2048x1536. 45-degree field of view: 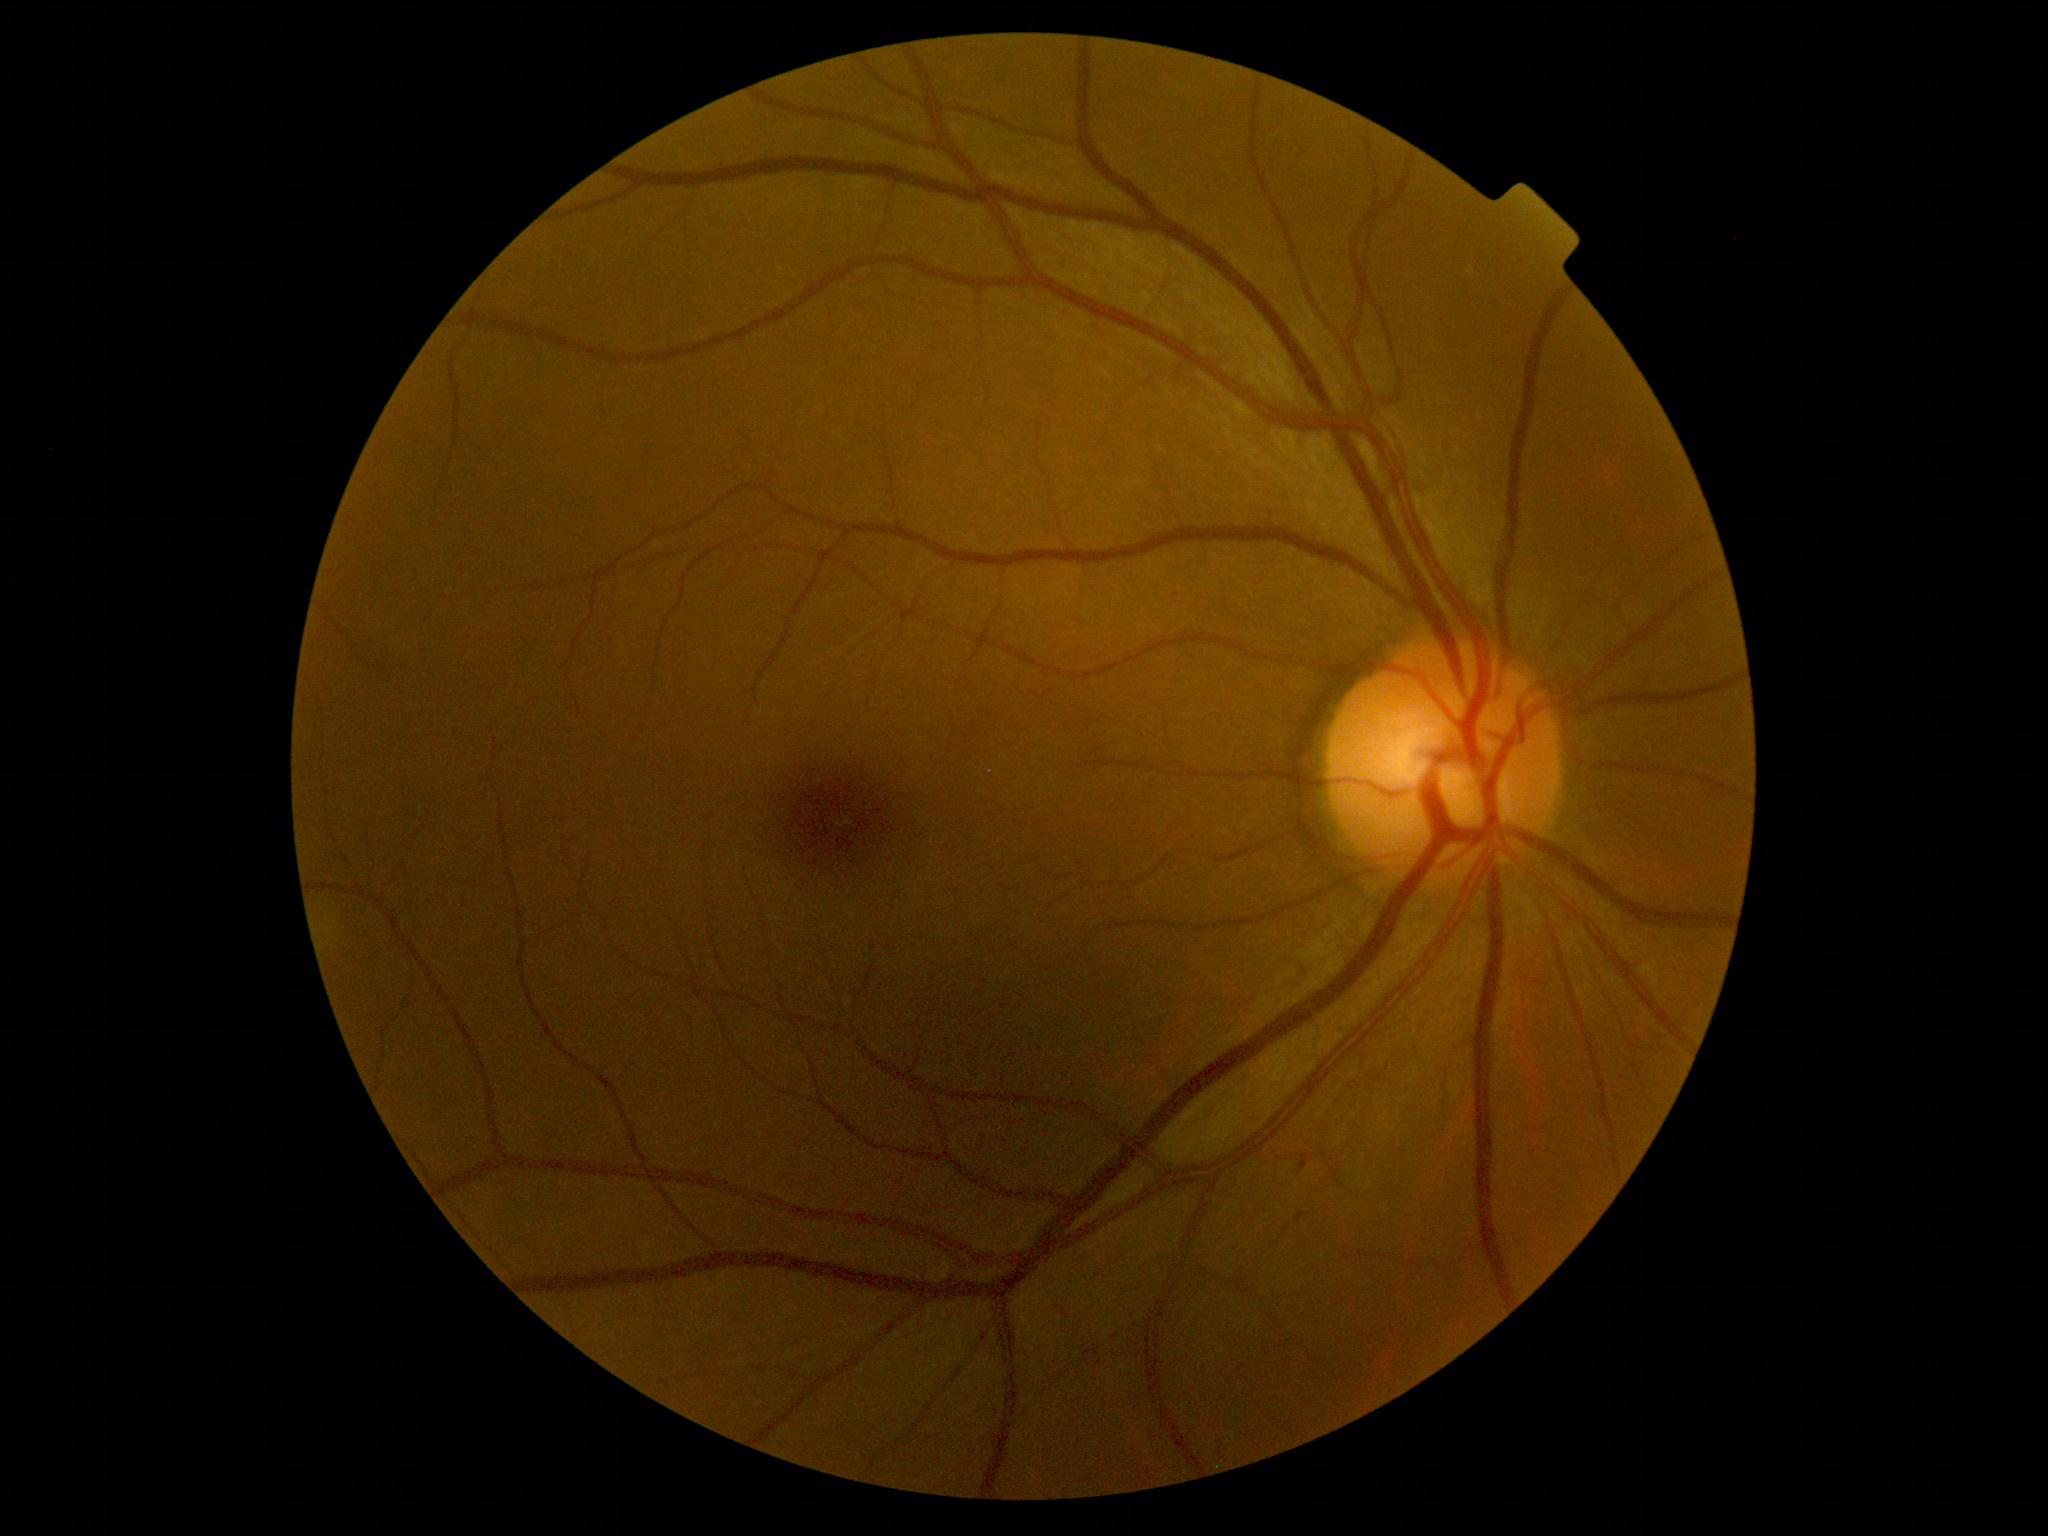
DR grade: mild non-proliferative diabetic retinopathy (1).